Tabletop color fundus camera image, 1534 by 1534 pixels: 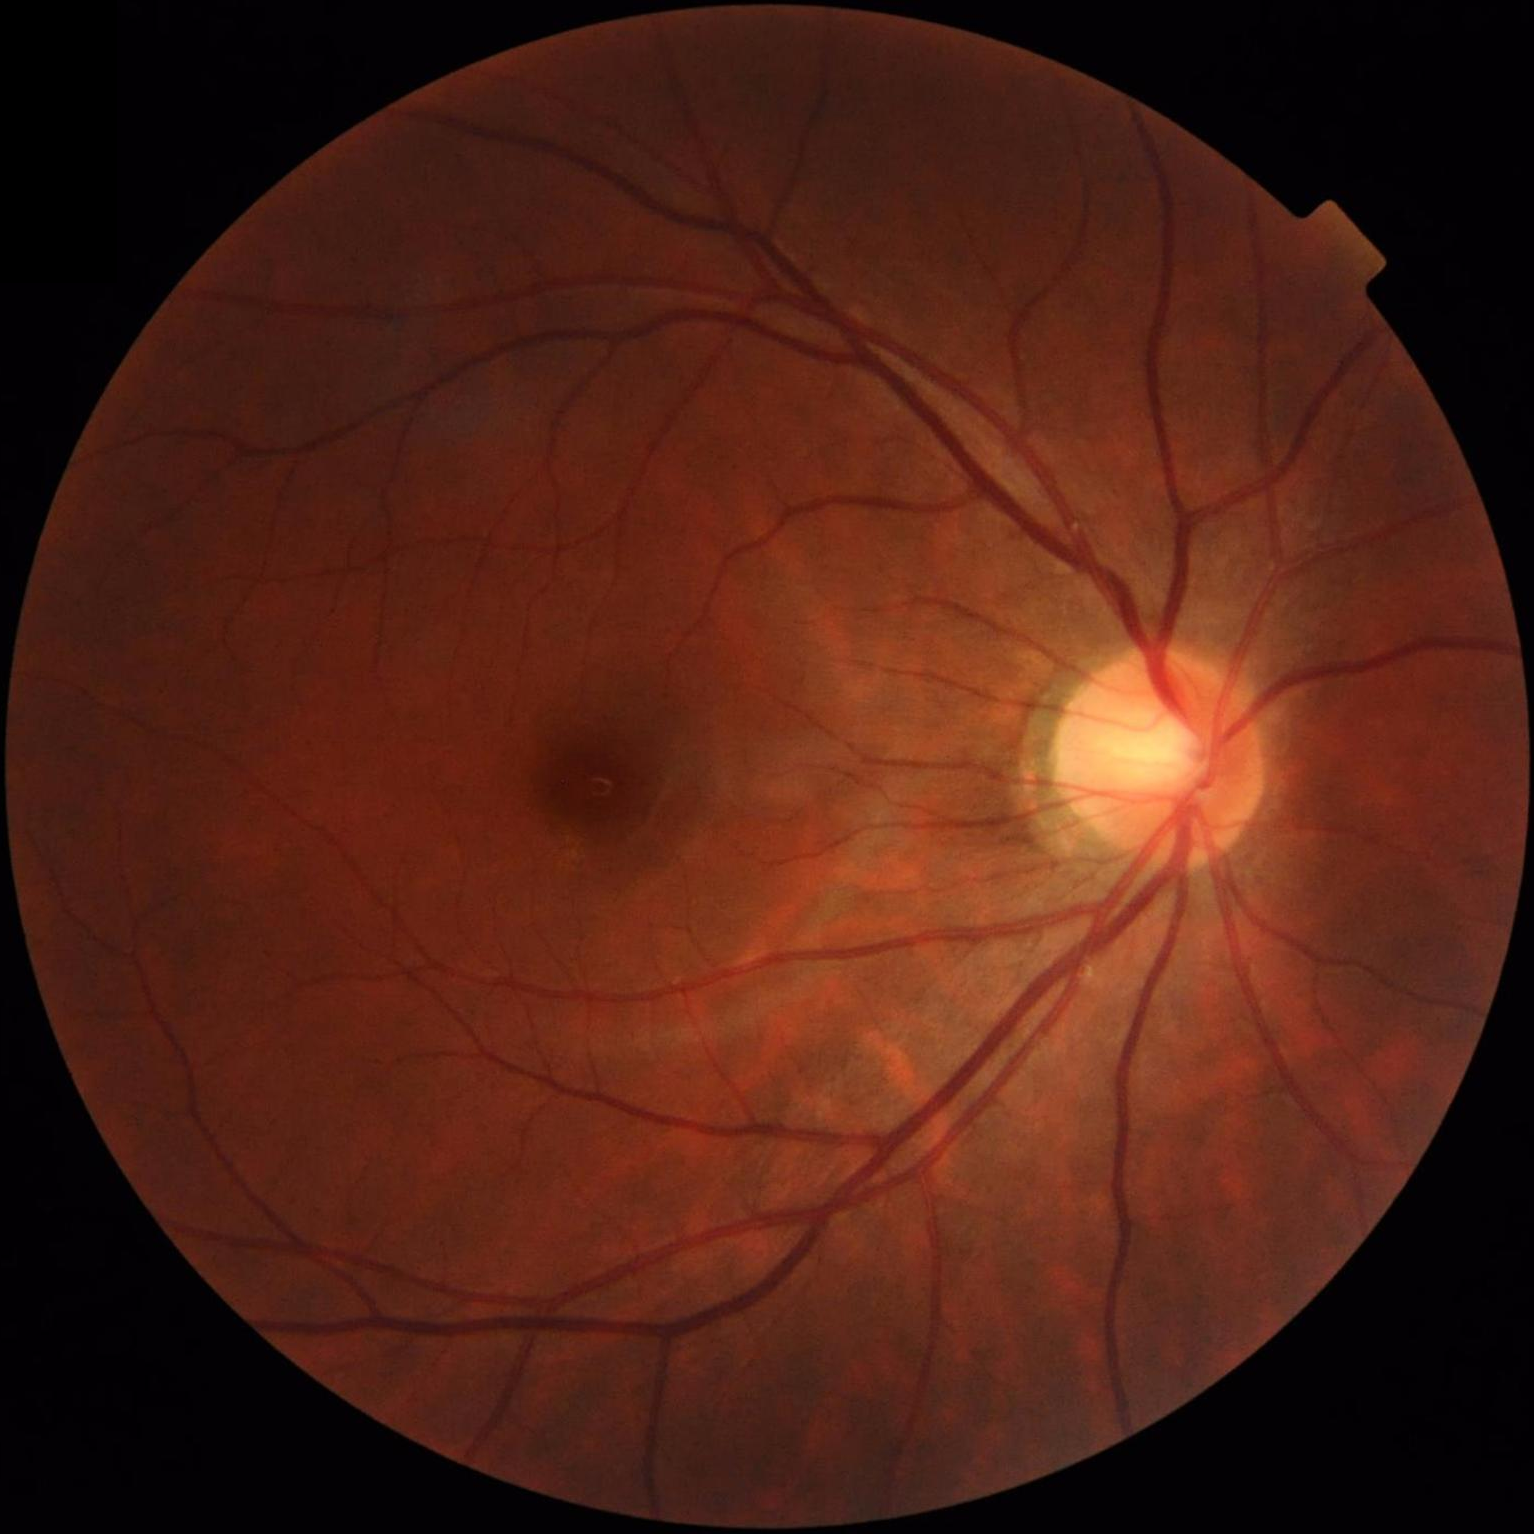
Illumination is even. Optic disc, vessels, and background are in focus. Overall quality is good and the image is gradable. Contrast is good.